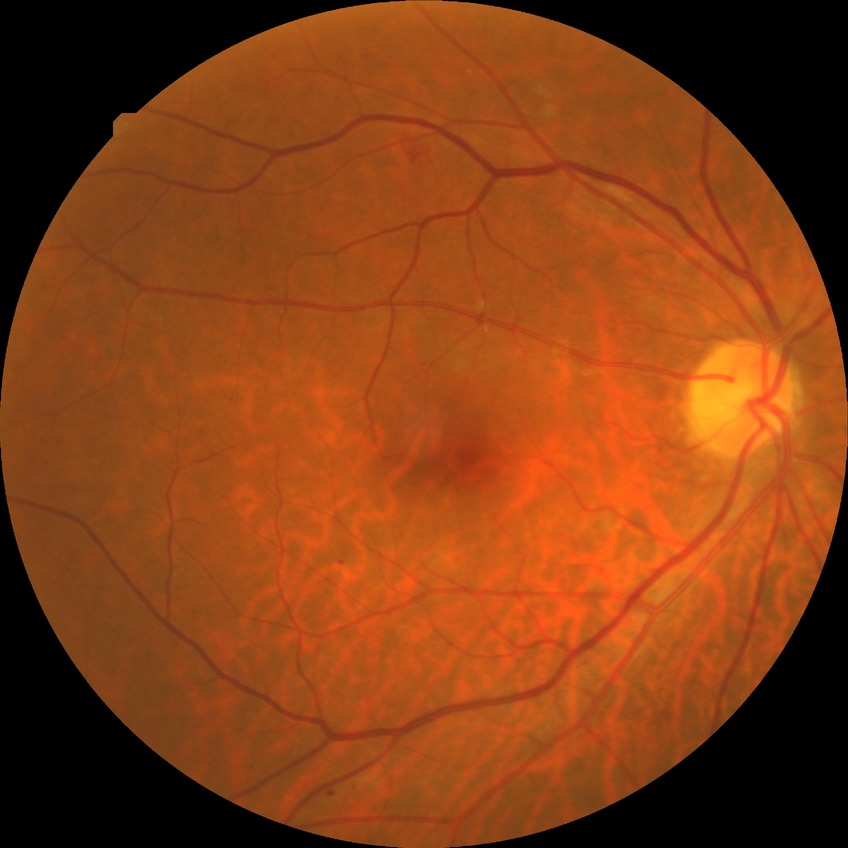 retinopathy stage: pre-proliferative diabetic retinopathy.